FOV: 45 degrees.
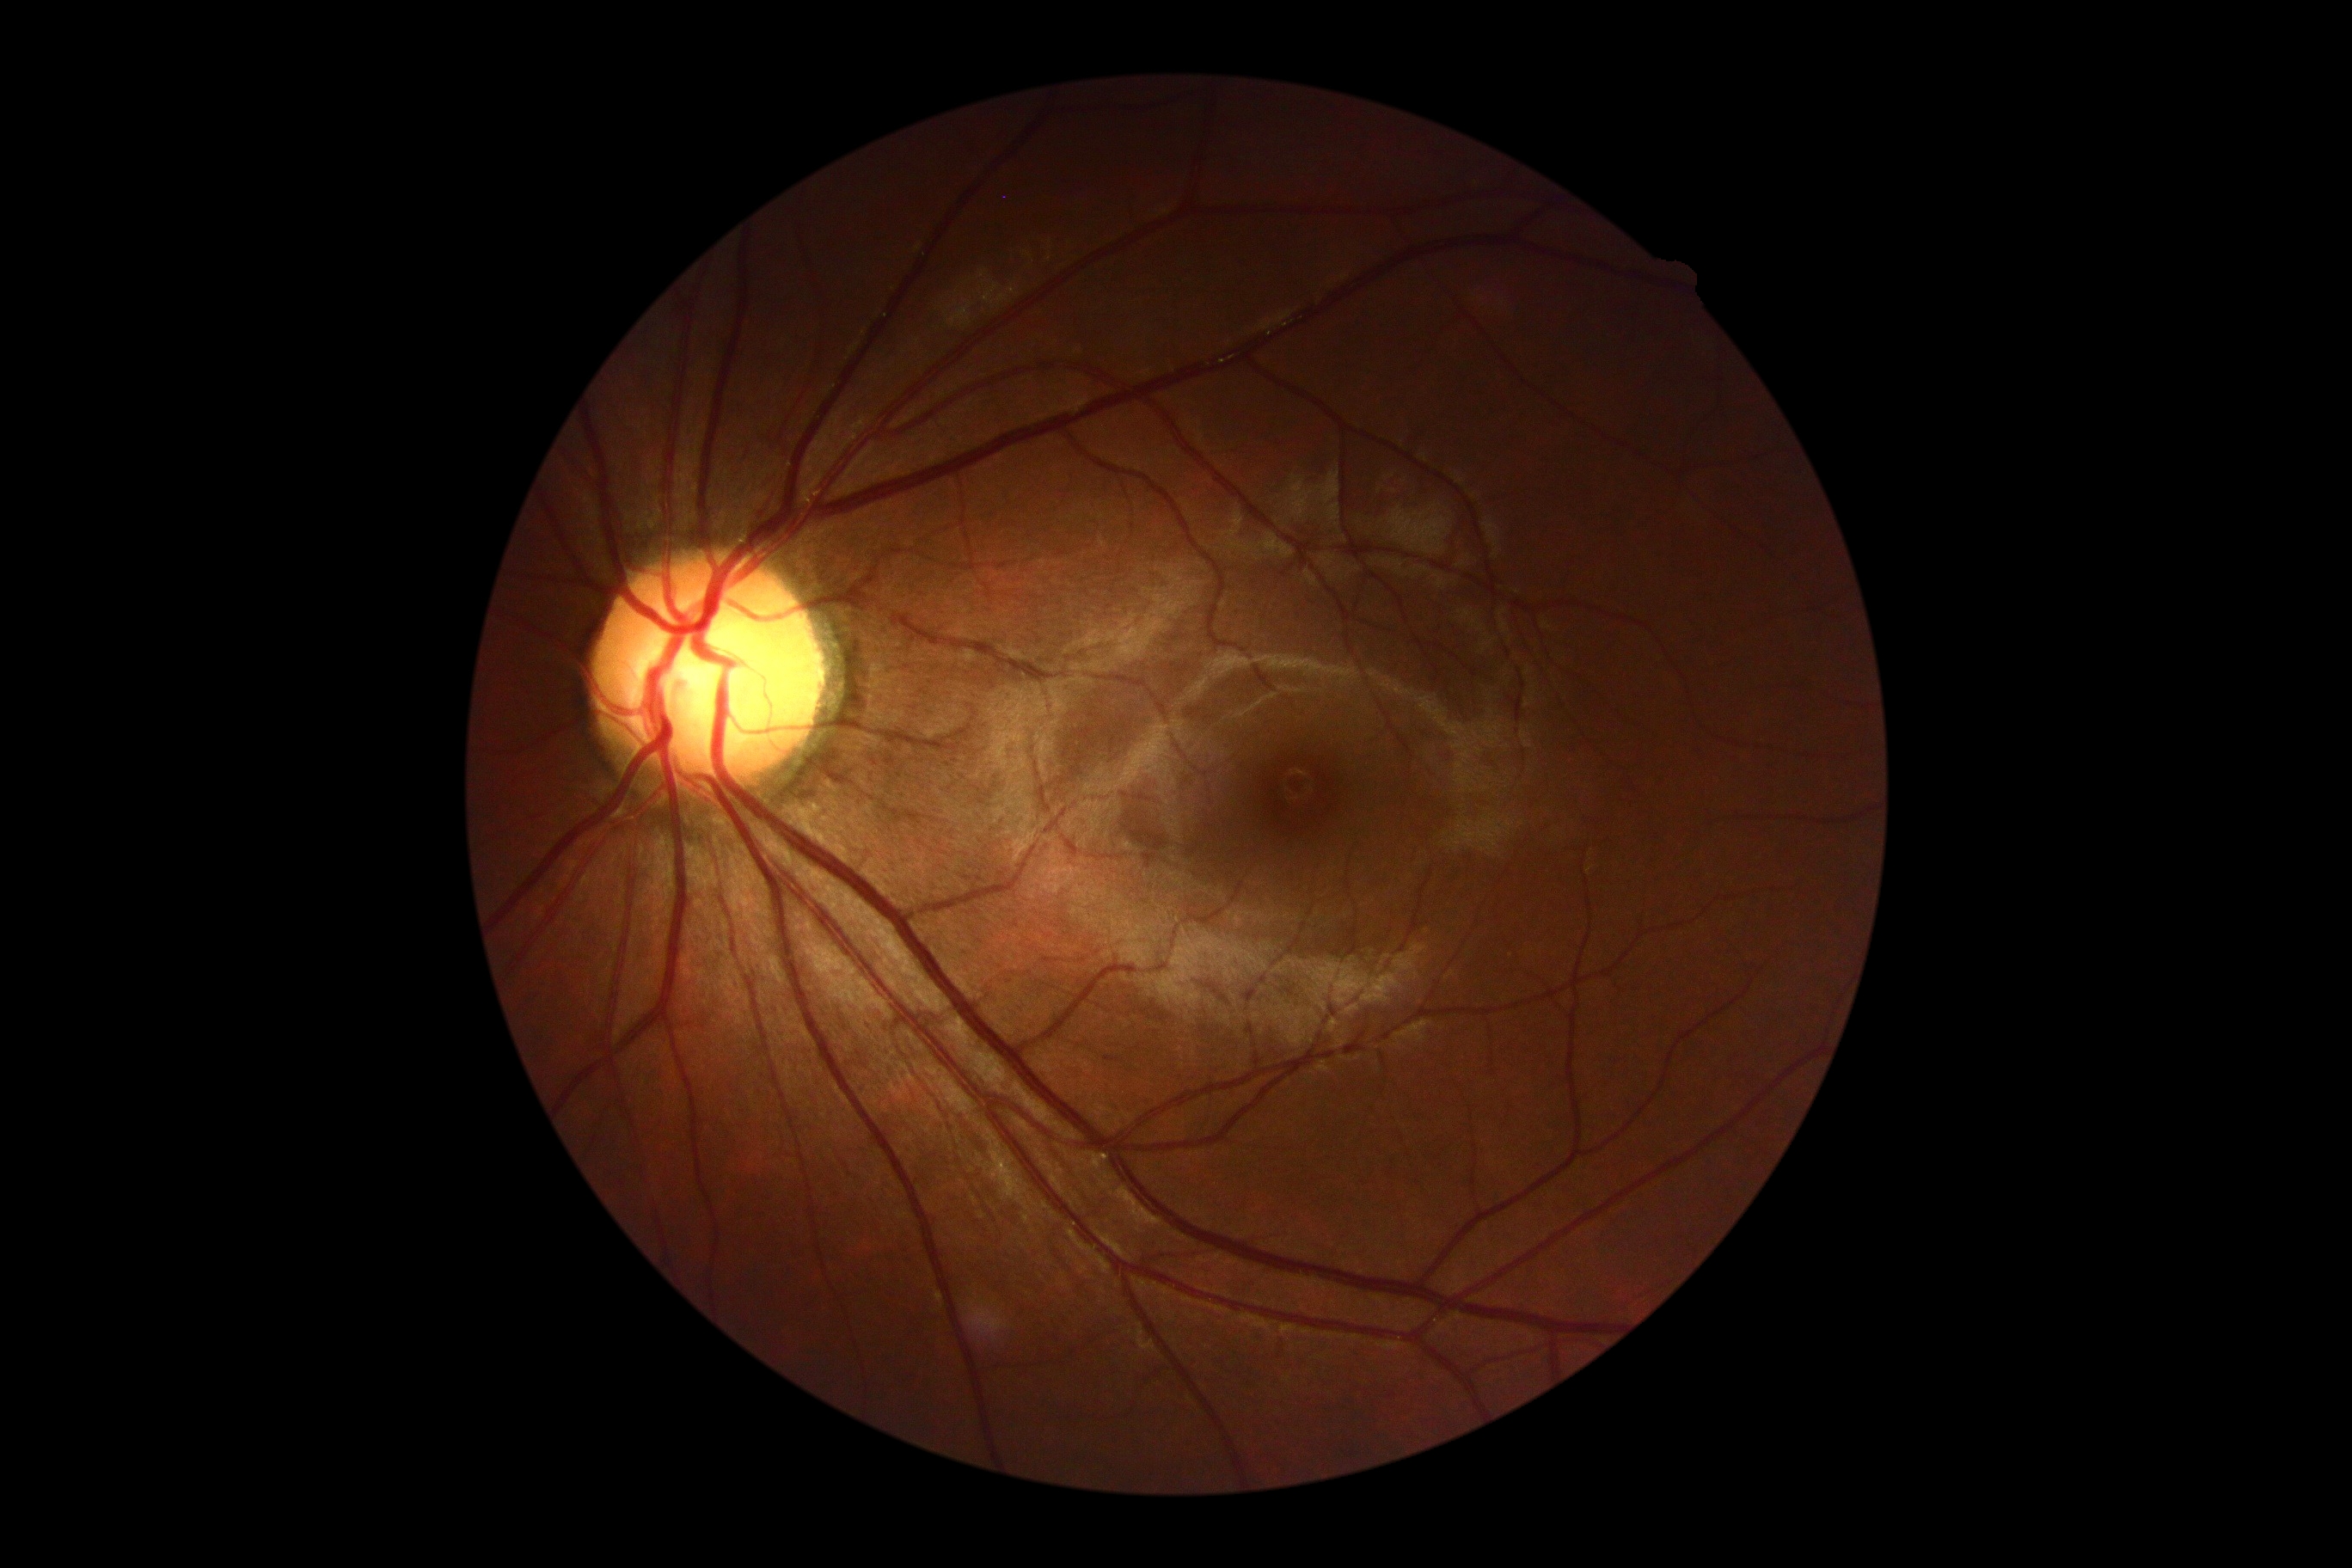
Retinopathy grade: no apparent diabetic retinopathy (0) — no visible signs of diabetic retinopathy.